2352 x 1568 pixels
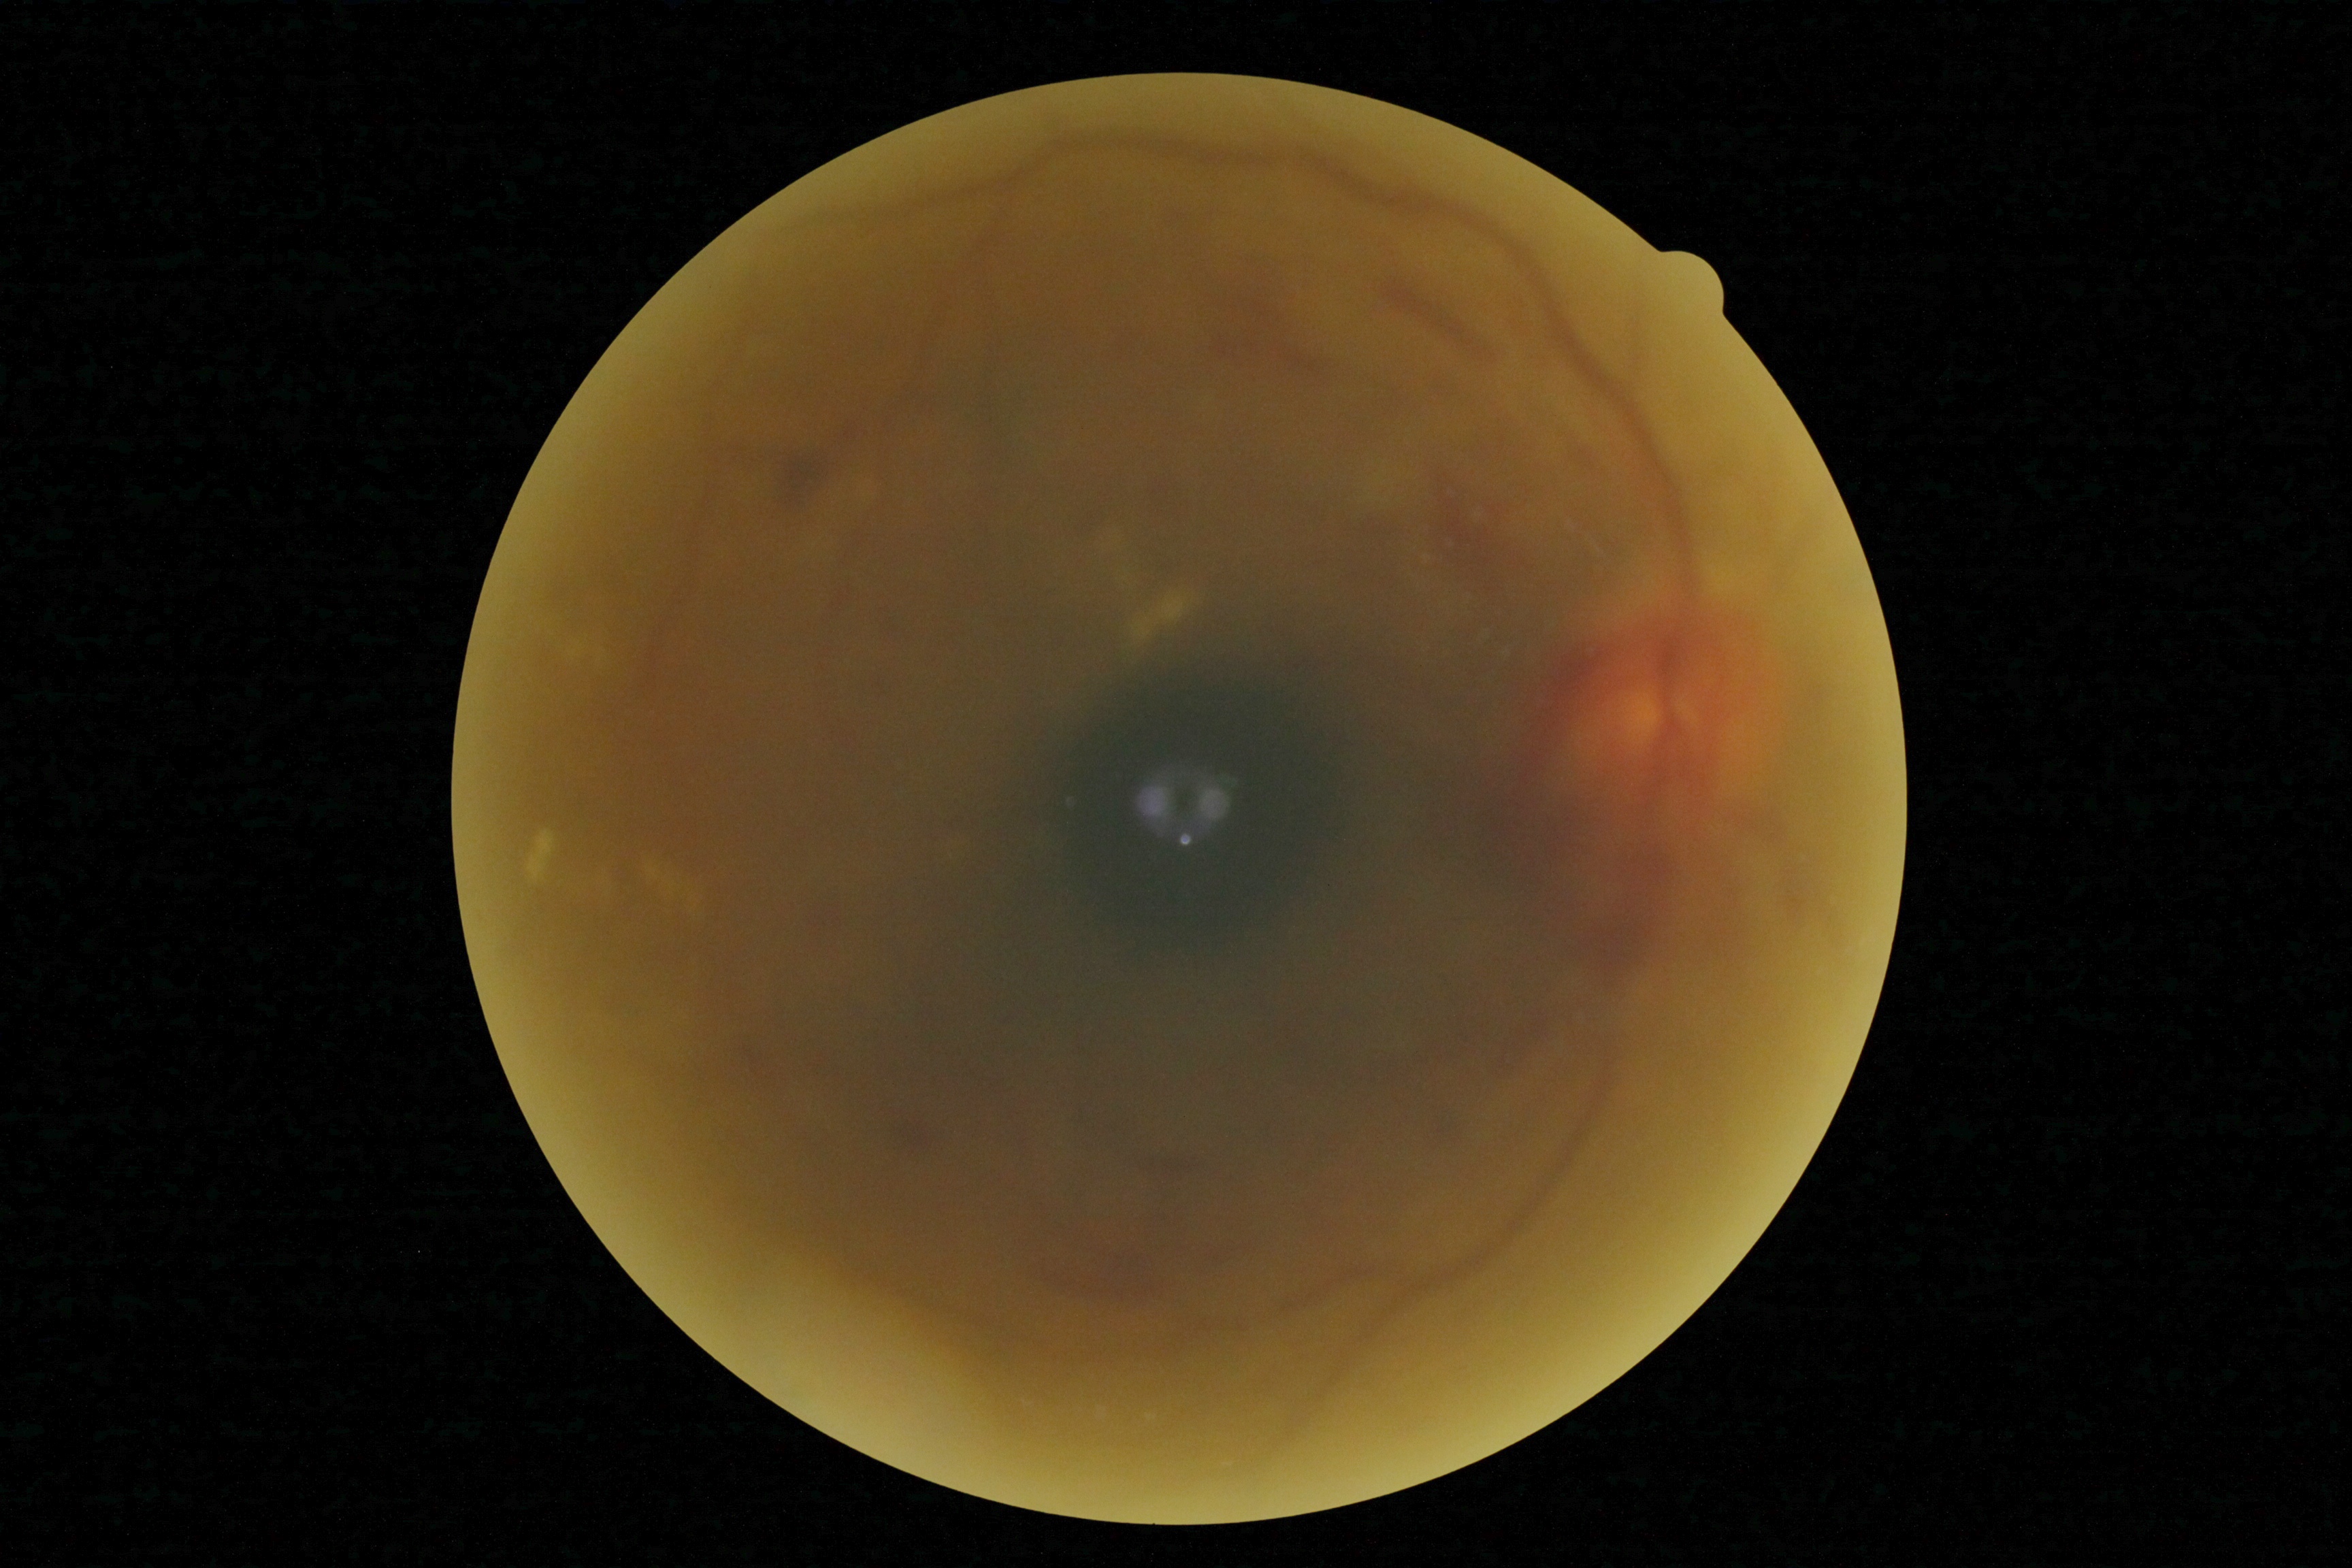
Diabetic retinopathy: grade 4 (PDR).